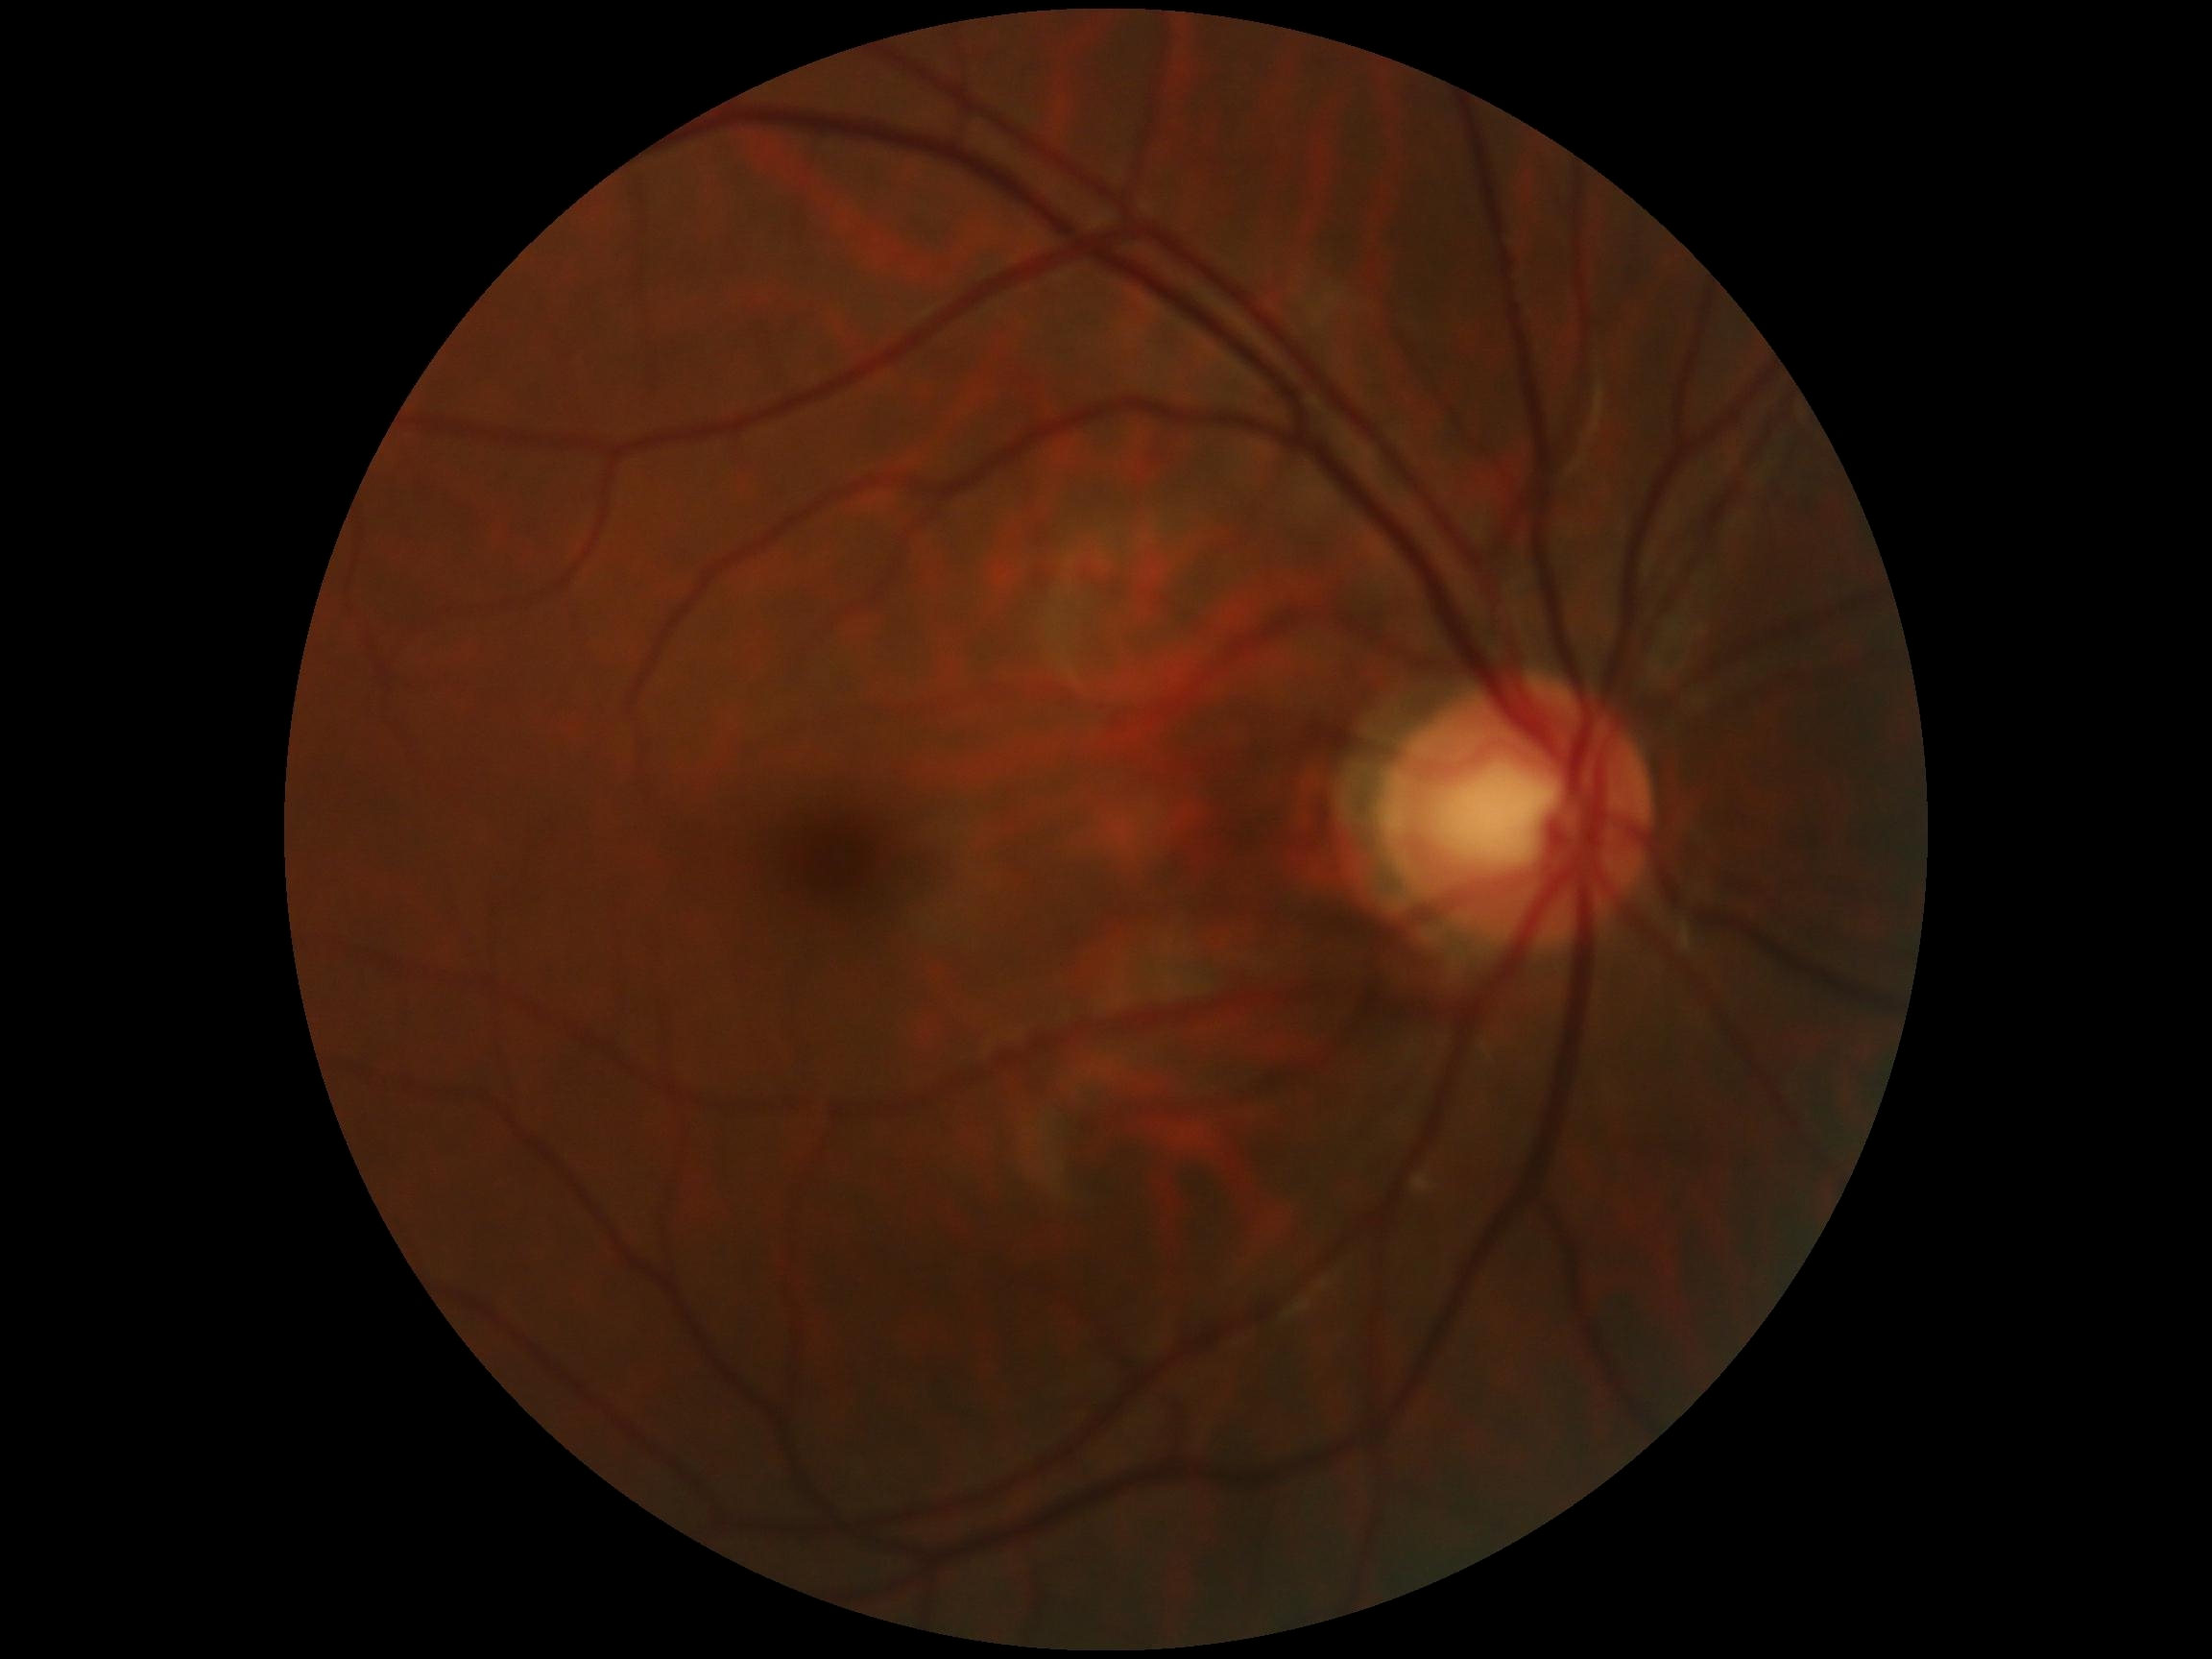
No diabetic retinal disease findings.
Retinopathy grade: 0 (no apparent retinopathy).